130° field of view (Clarity RetCam 3); pediatric wide-field fundus photograph: 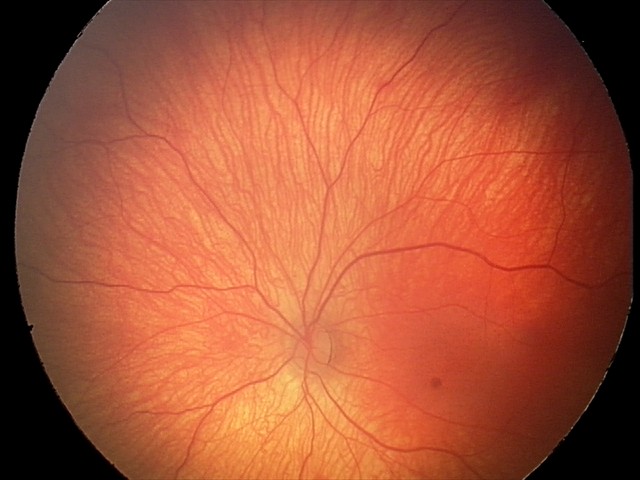

Q: What is the diagnosis from this examination?
A: retinal hemorrhages